45° field of view; fundus photo — 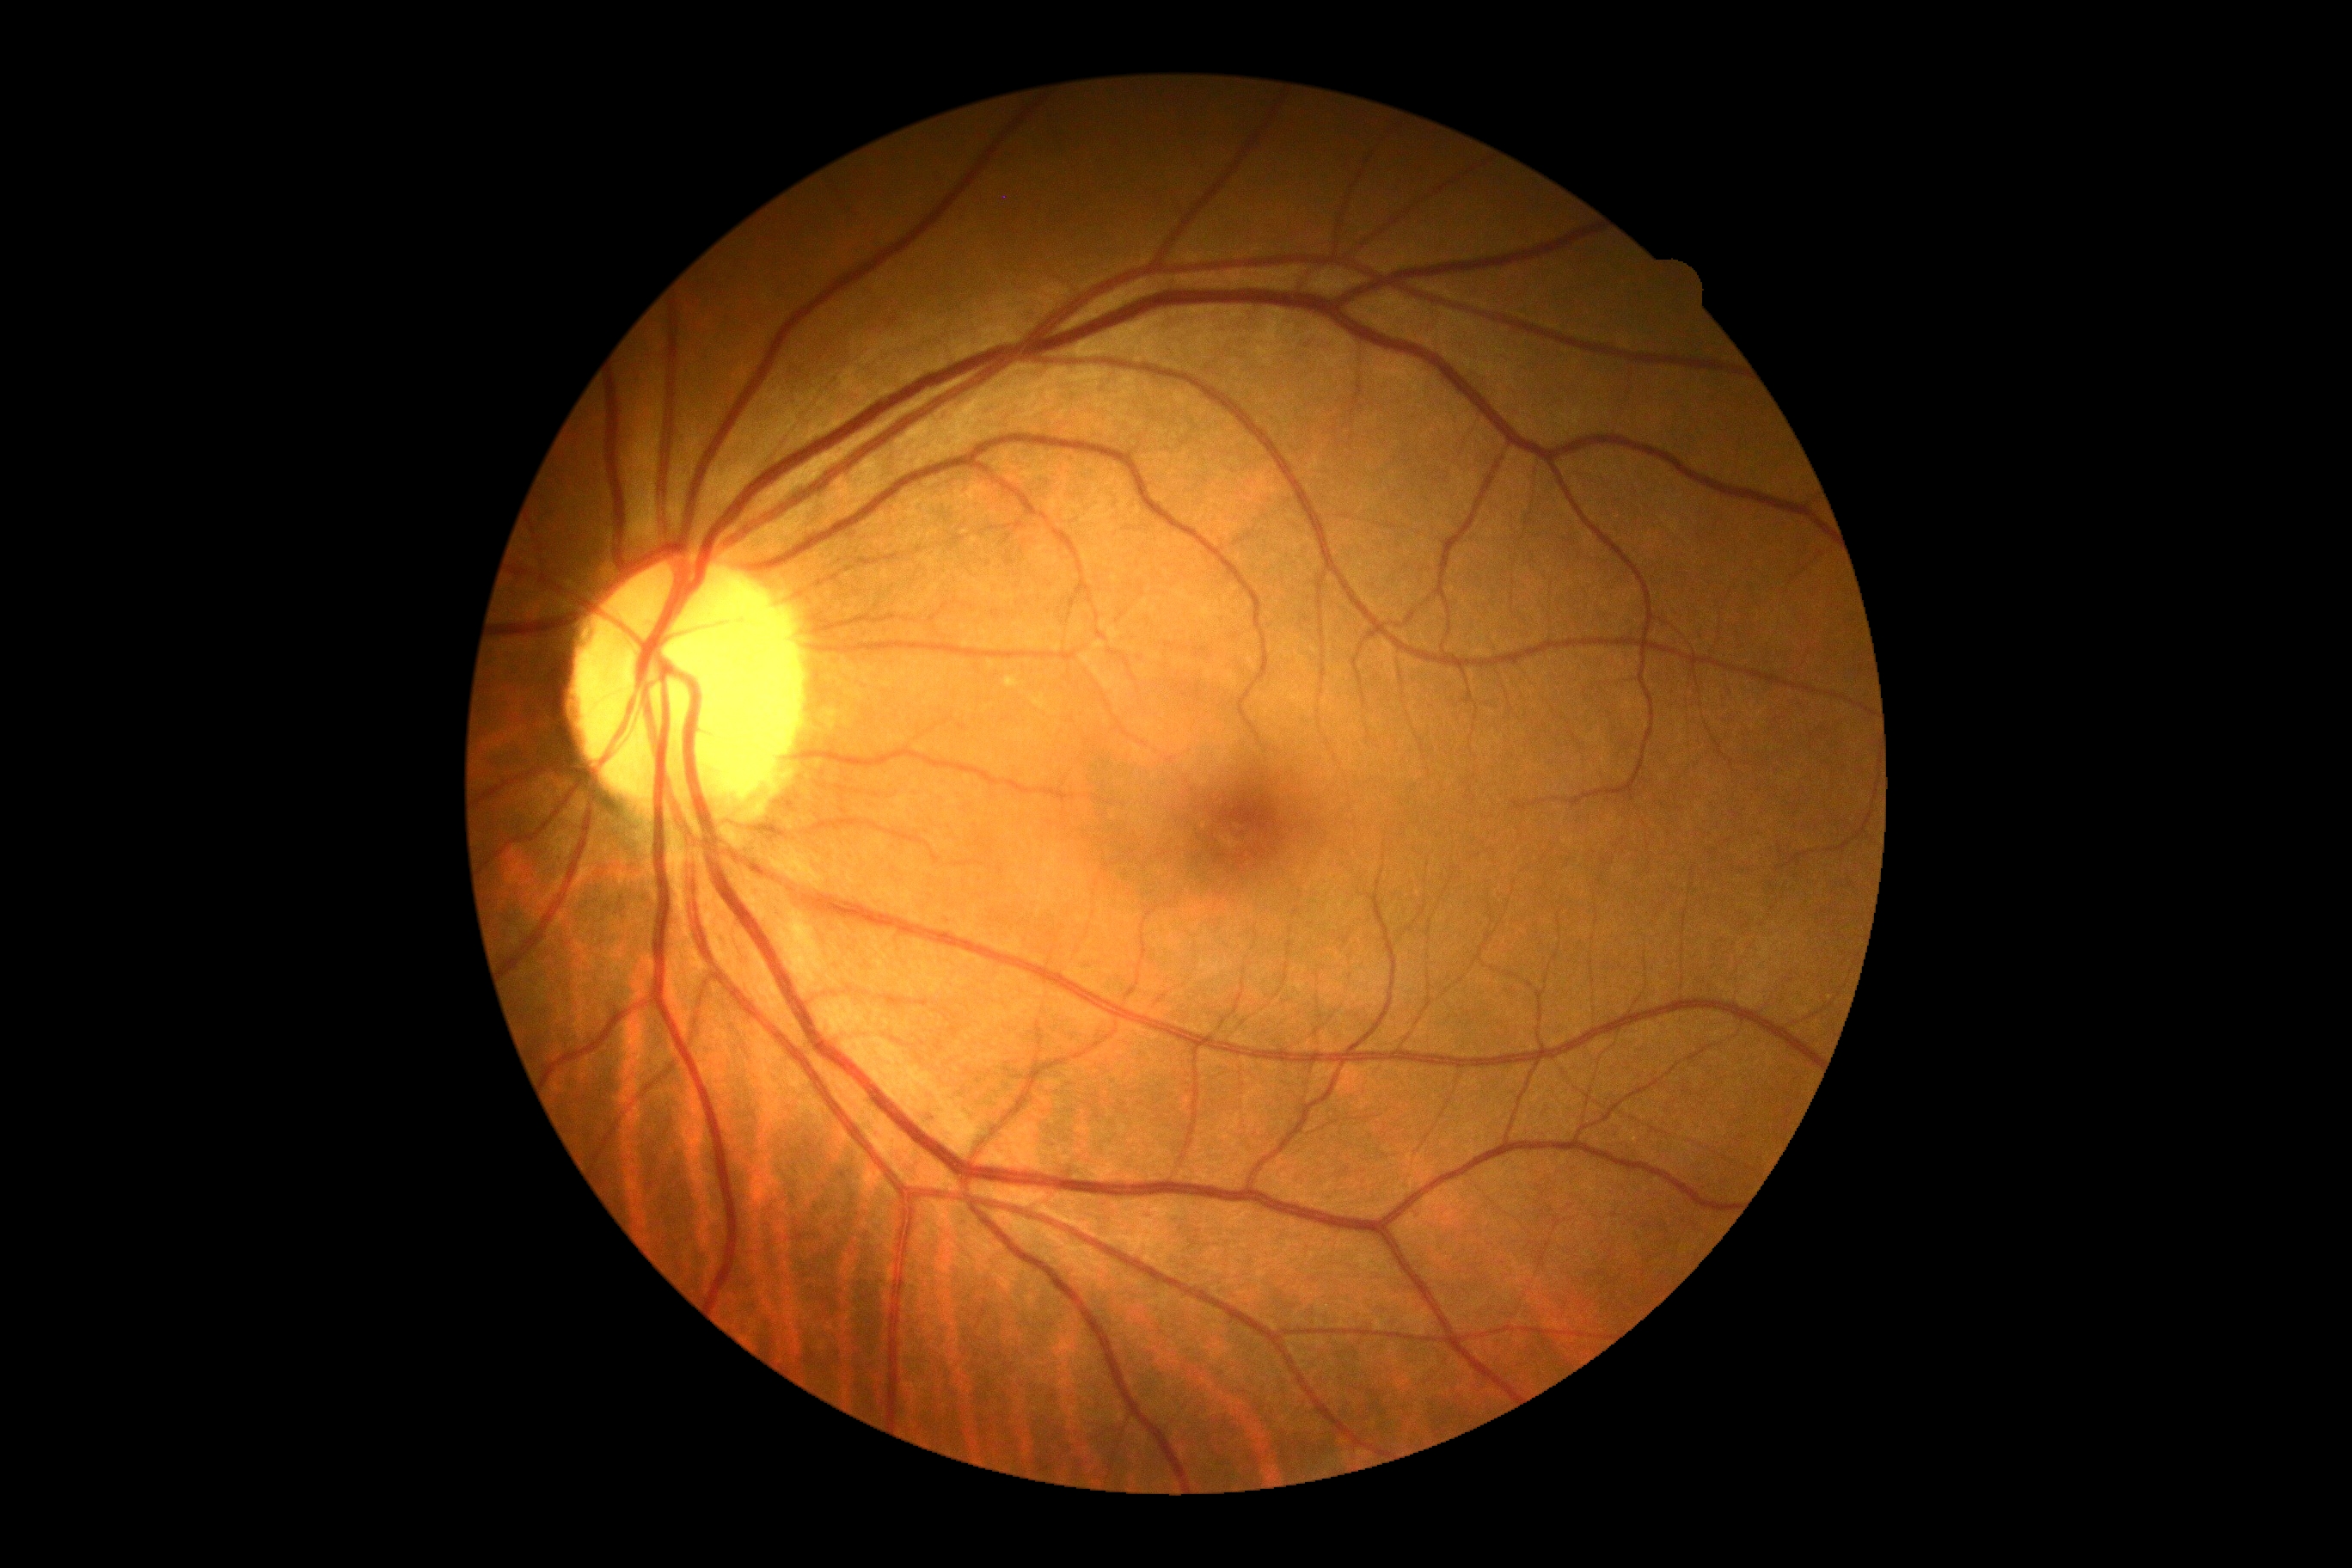

No DR findings. Diabetic retinopathy is no apparent retinopathy (grade 0).